Infant wide-field fundus photograph. 640x480:
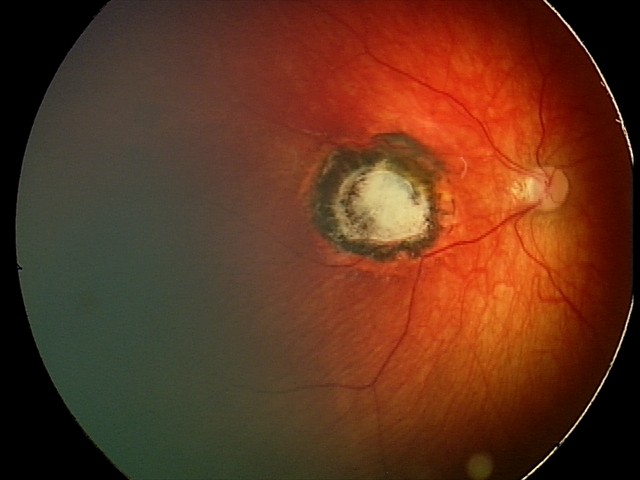
Assessment: toxoplasmosis chorioretinitis.